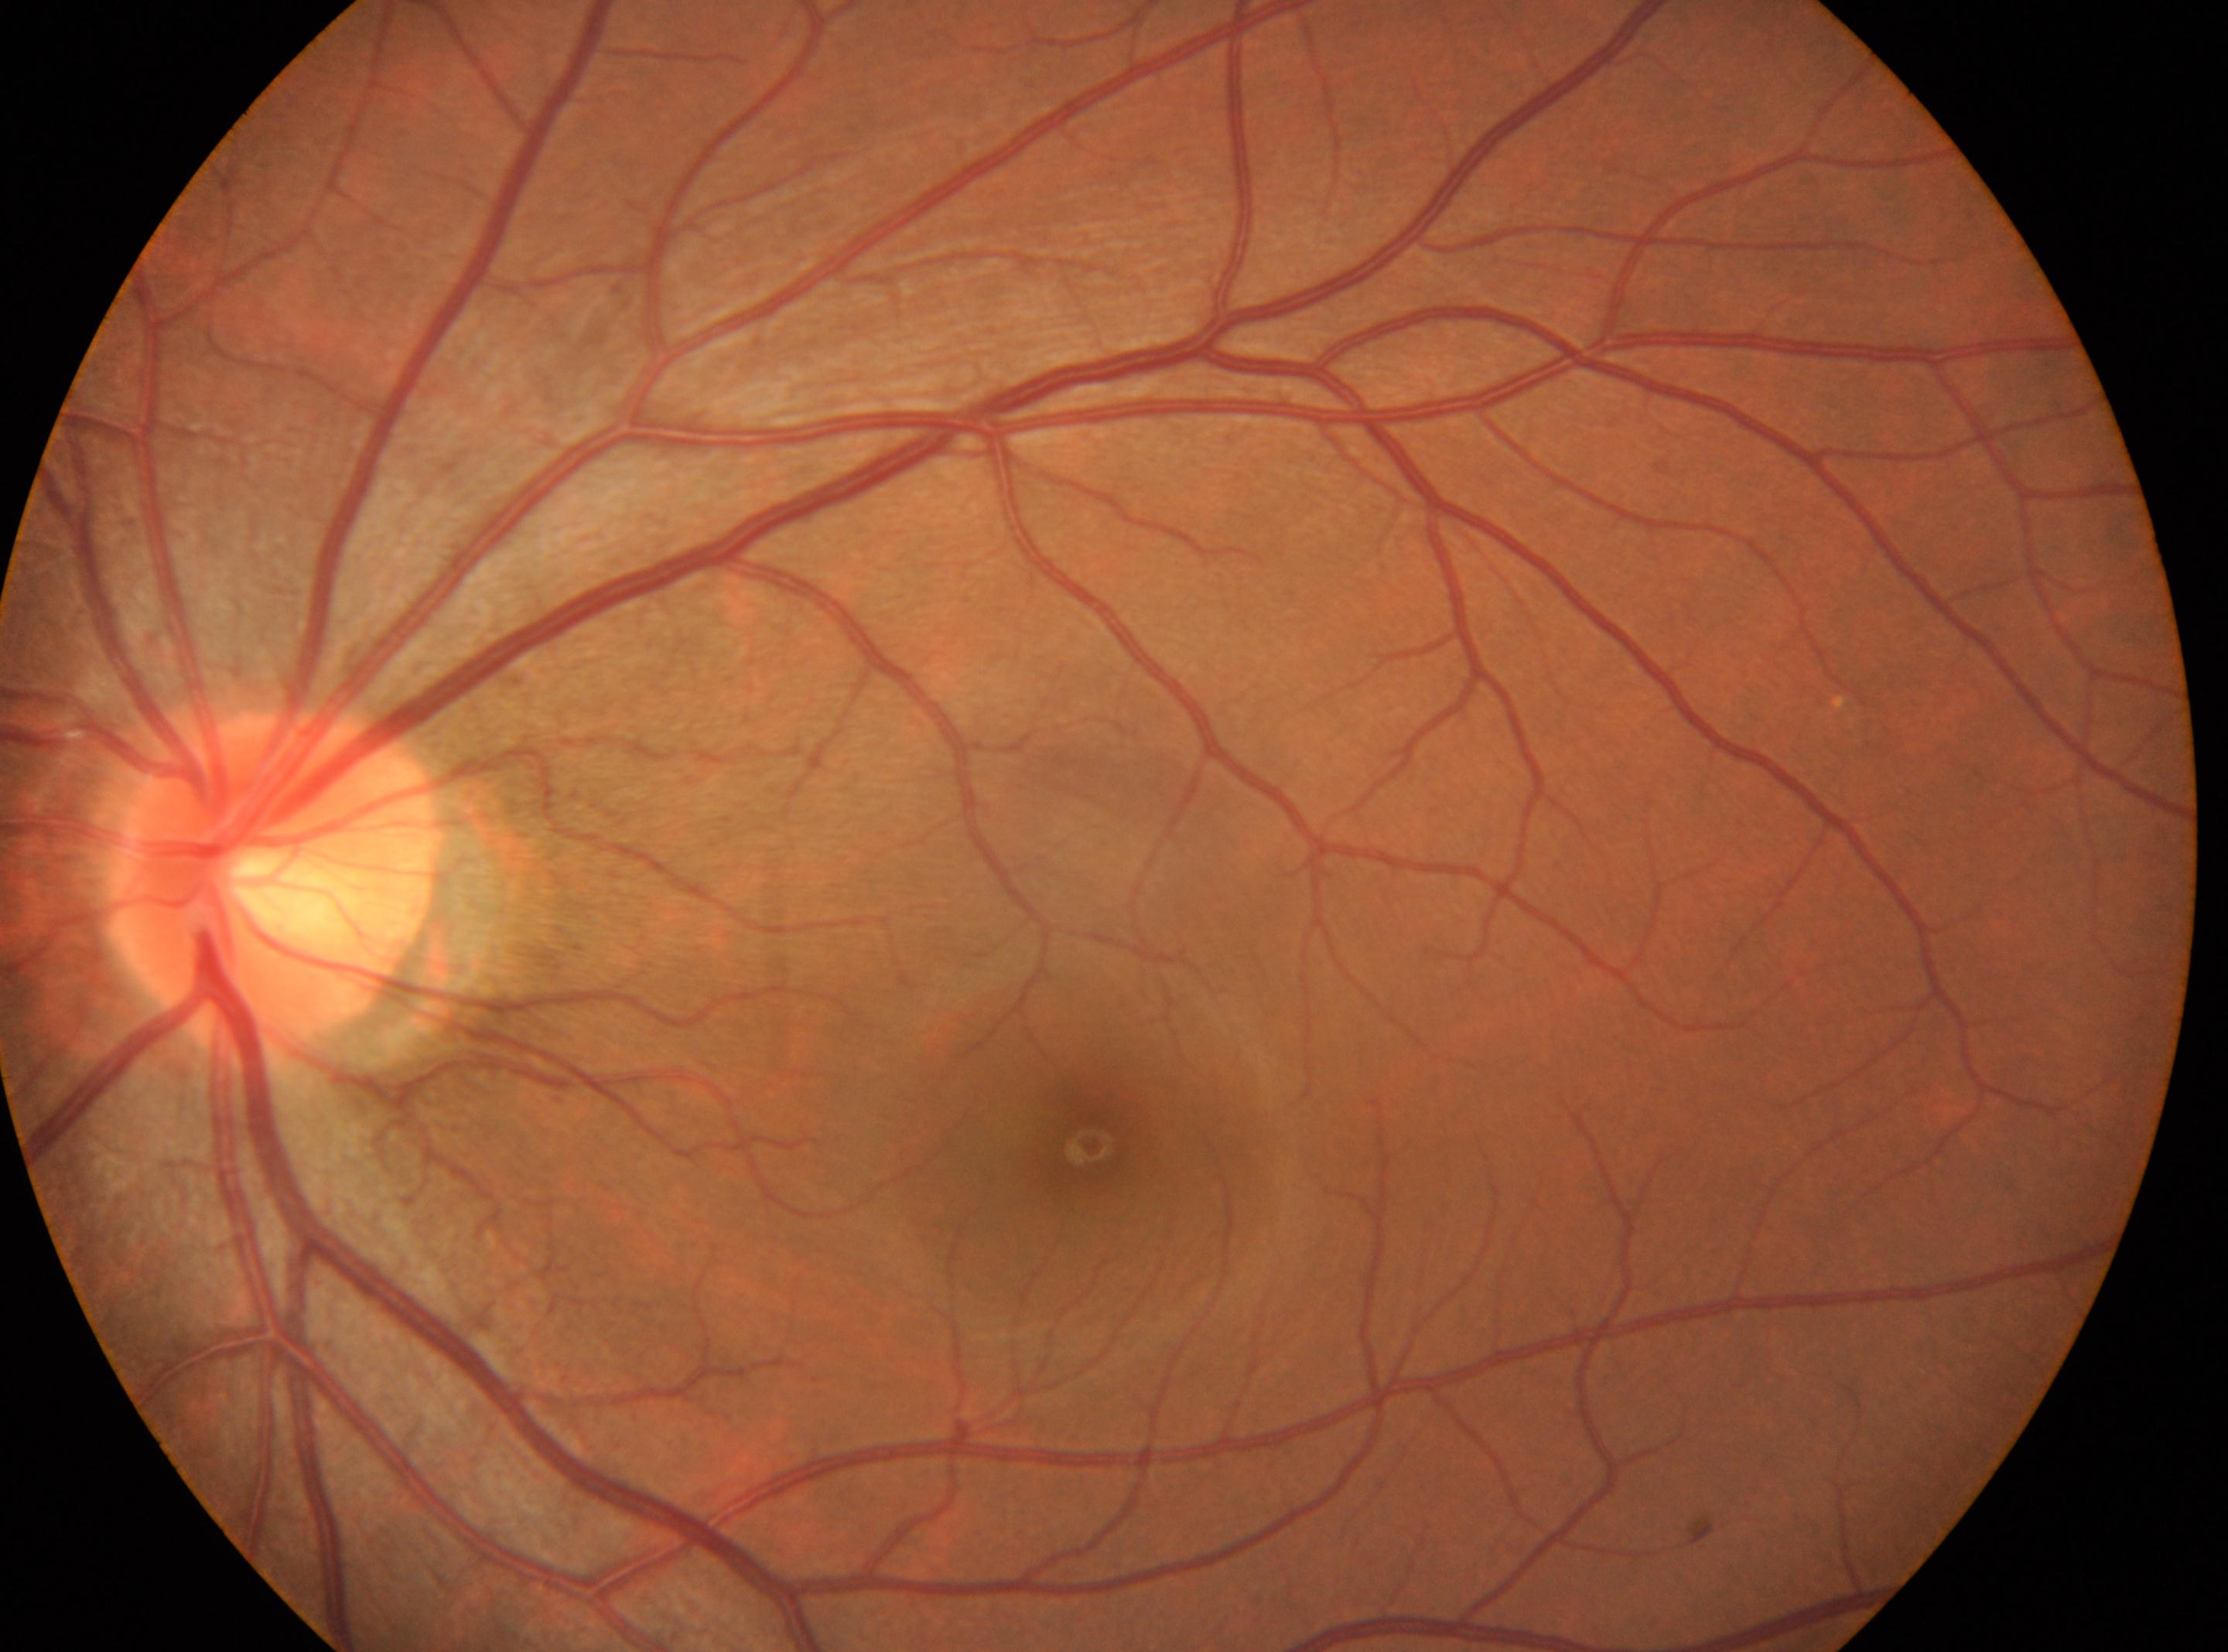 The optic disk is at (272,889). The fovea is at (1089,1143). Eye: the left eye. Diabetic retinopathy (DR) is no apparent diabetic retinopathy (grade 0).